Diabetic retinopathy graded by the modified Davis classification:
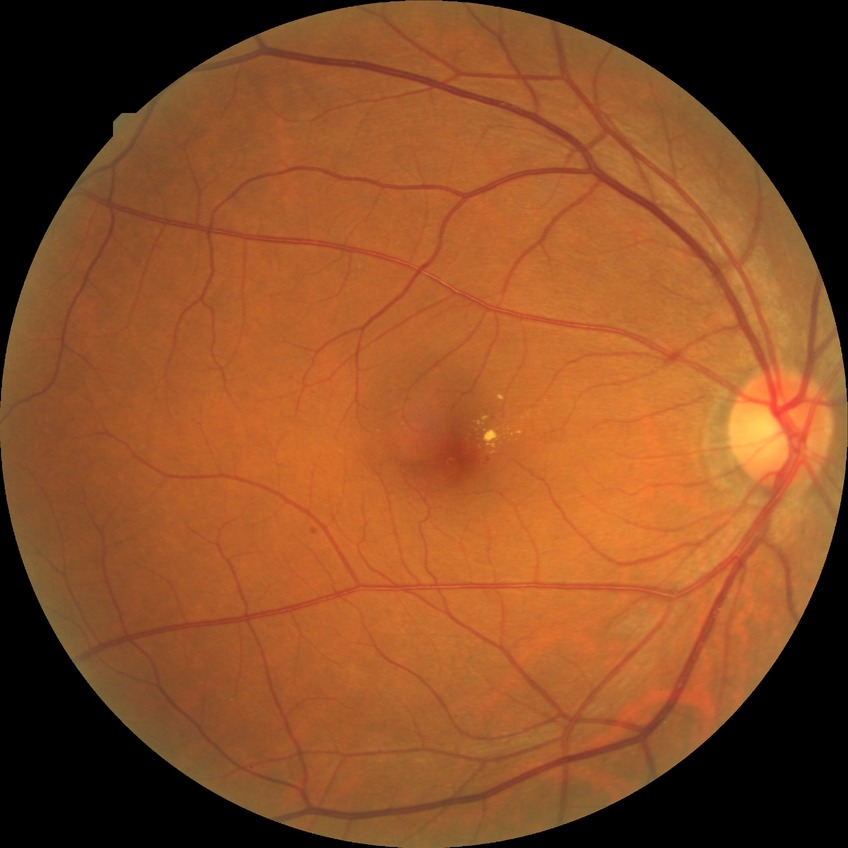 retinopathy grade: simple diabetic retinopathy.